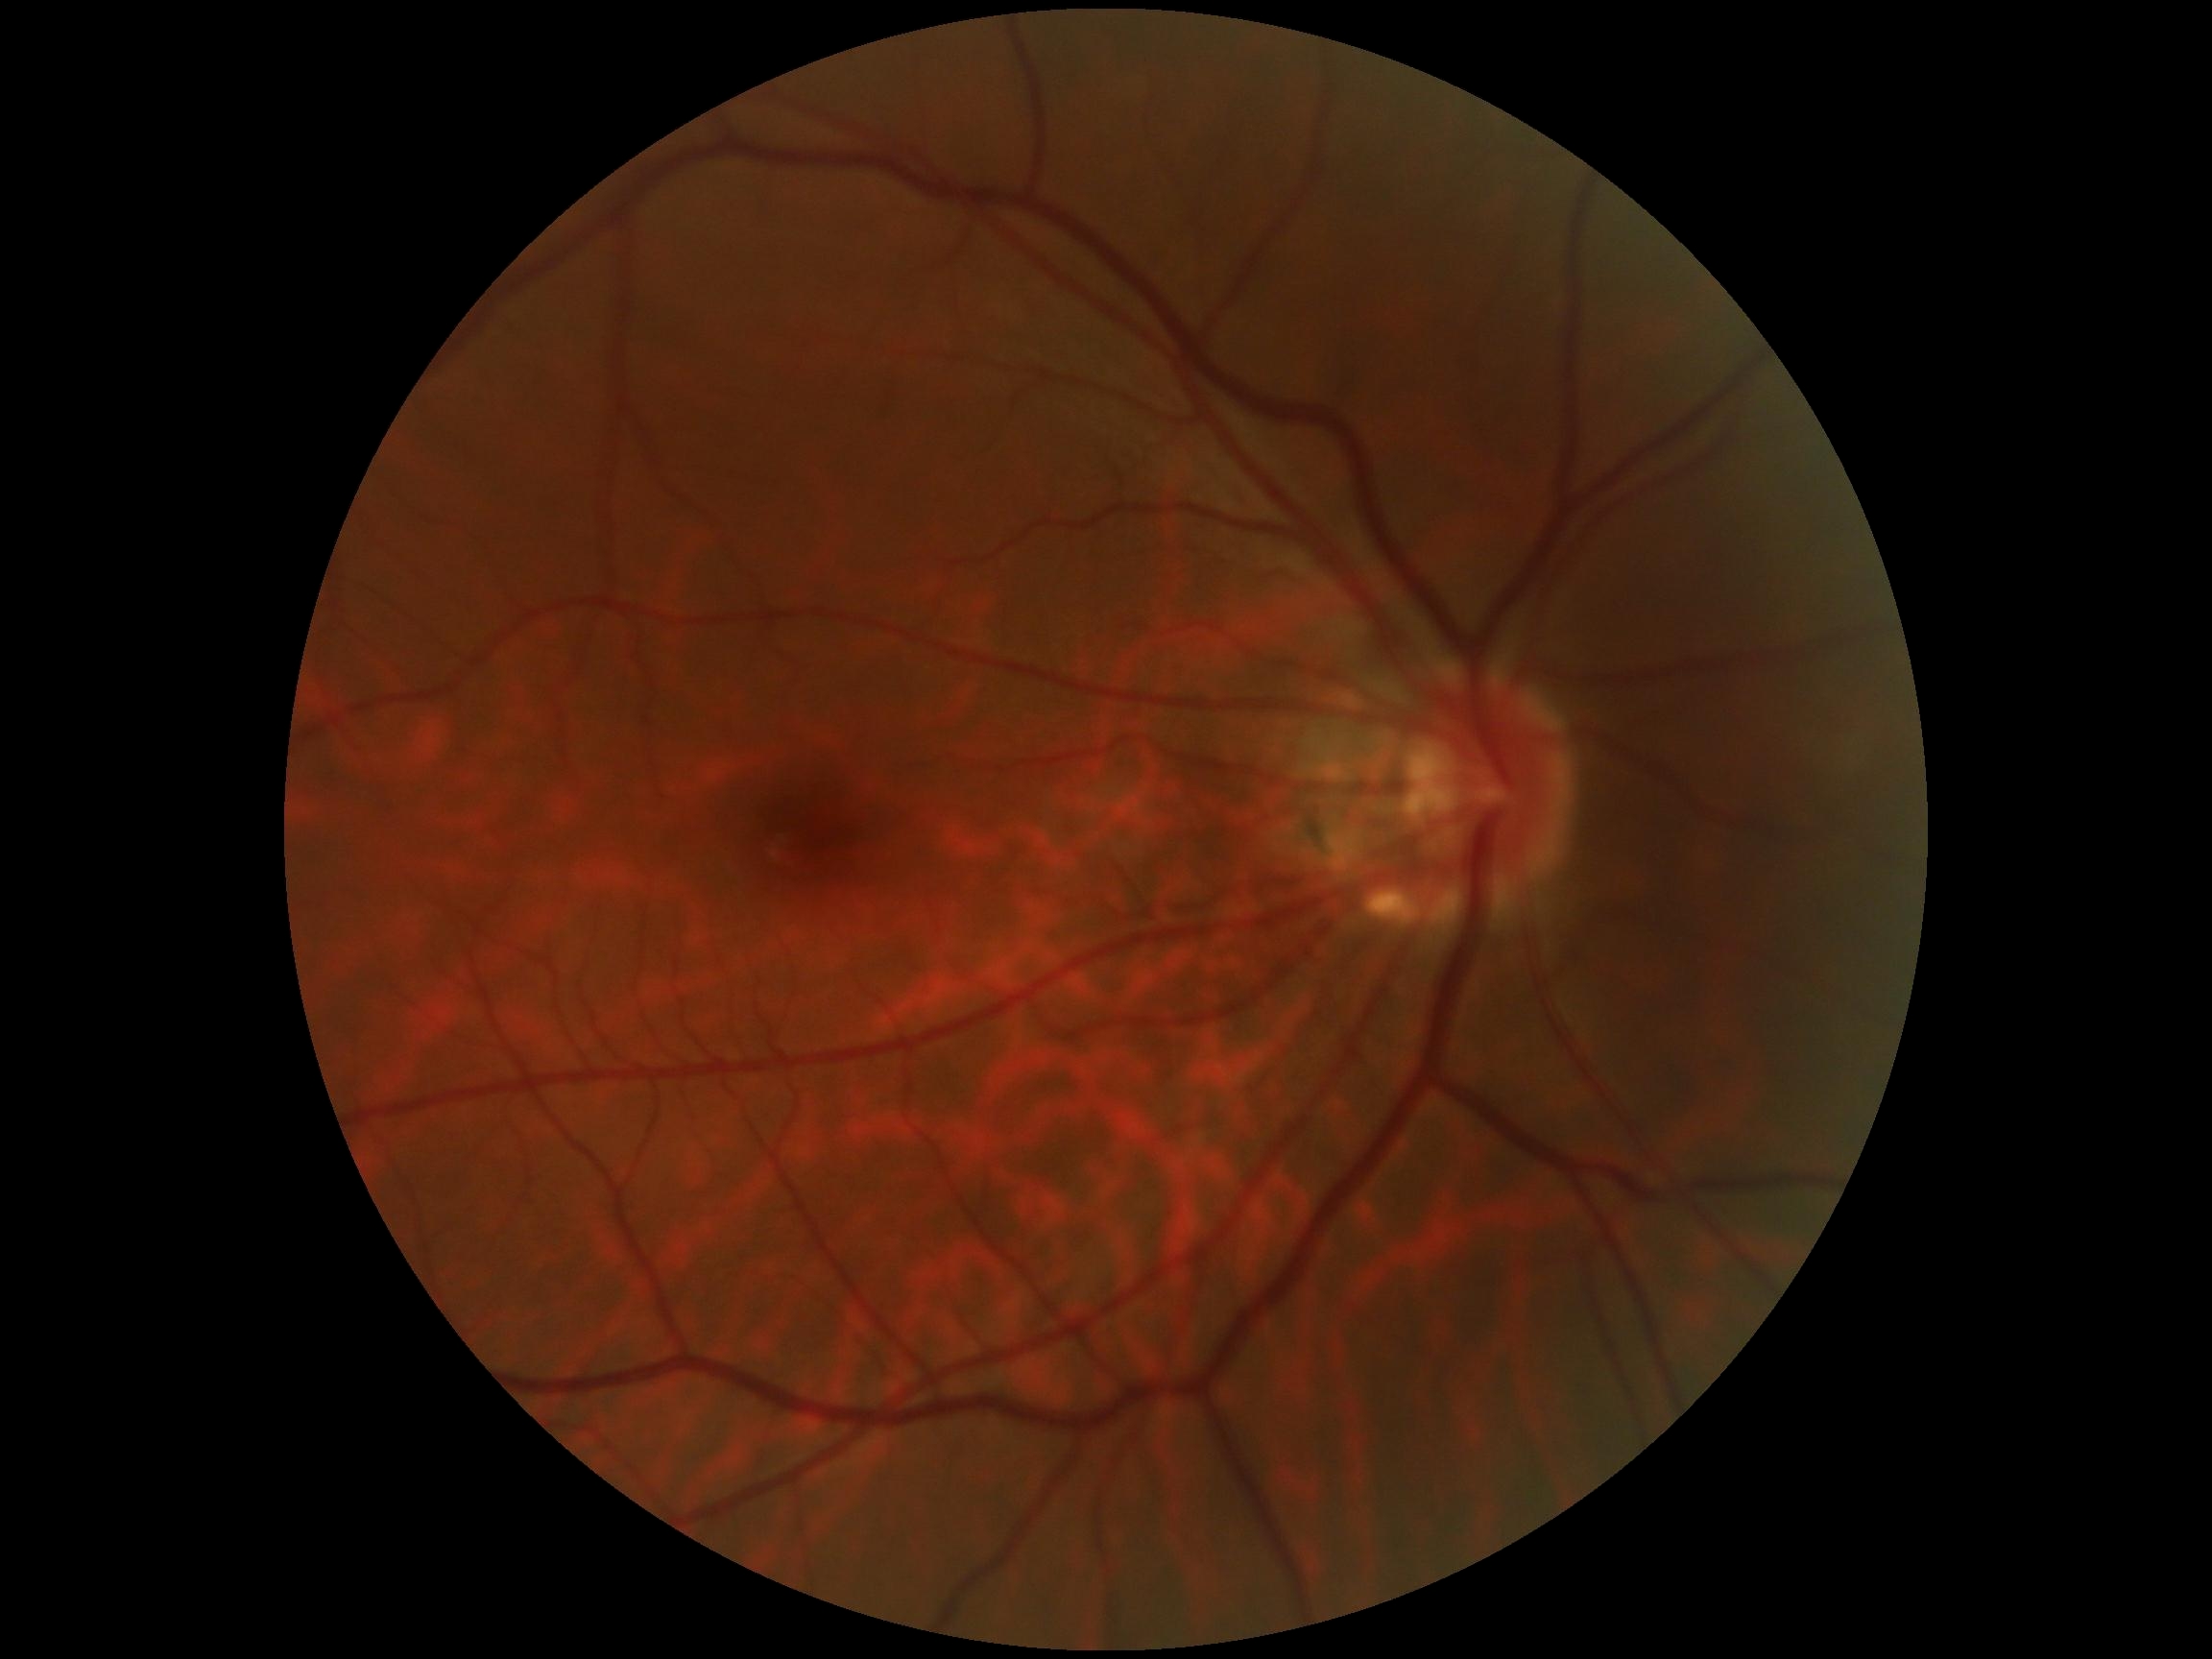 No signs of diabetic retinopathy. DR stage is no apparent diabetic retinopathy (grade 0) — no visible signs of diabetic retinopathy.